Graded on the modified Davis scale, image size 848x848.
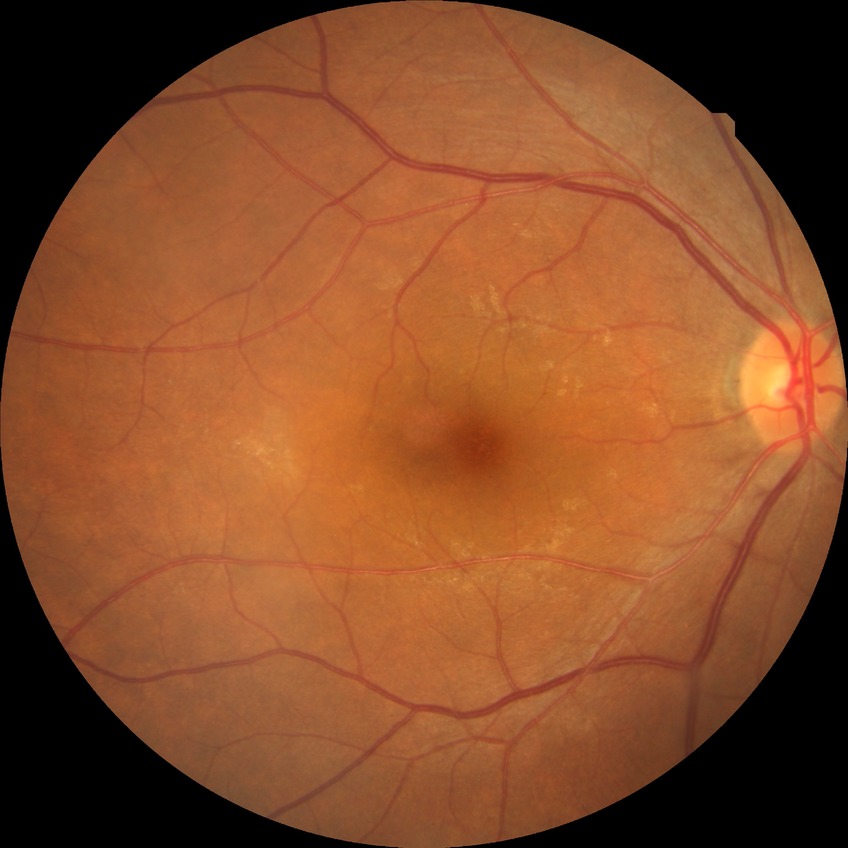 diabetic retinopathy stage: no diabetic retinopathy.